Color fundus photograph: 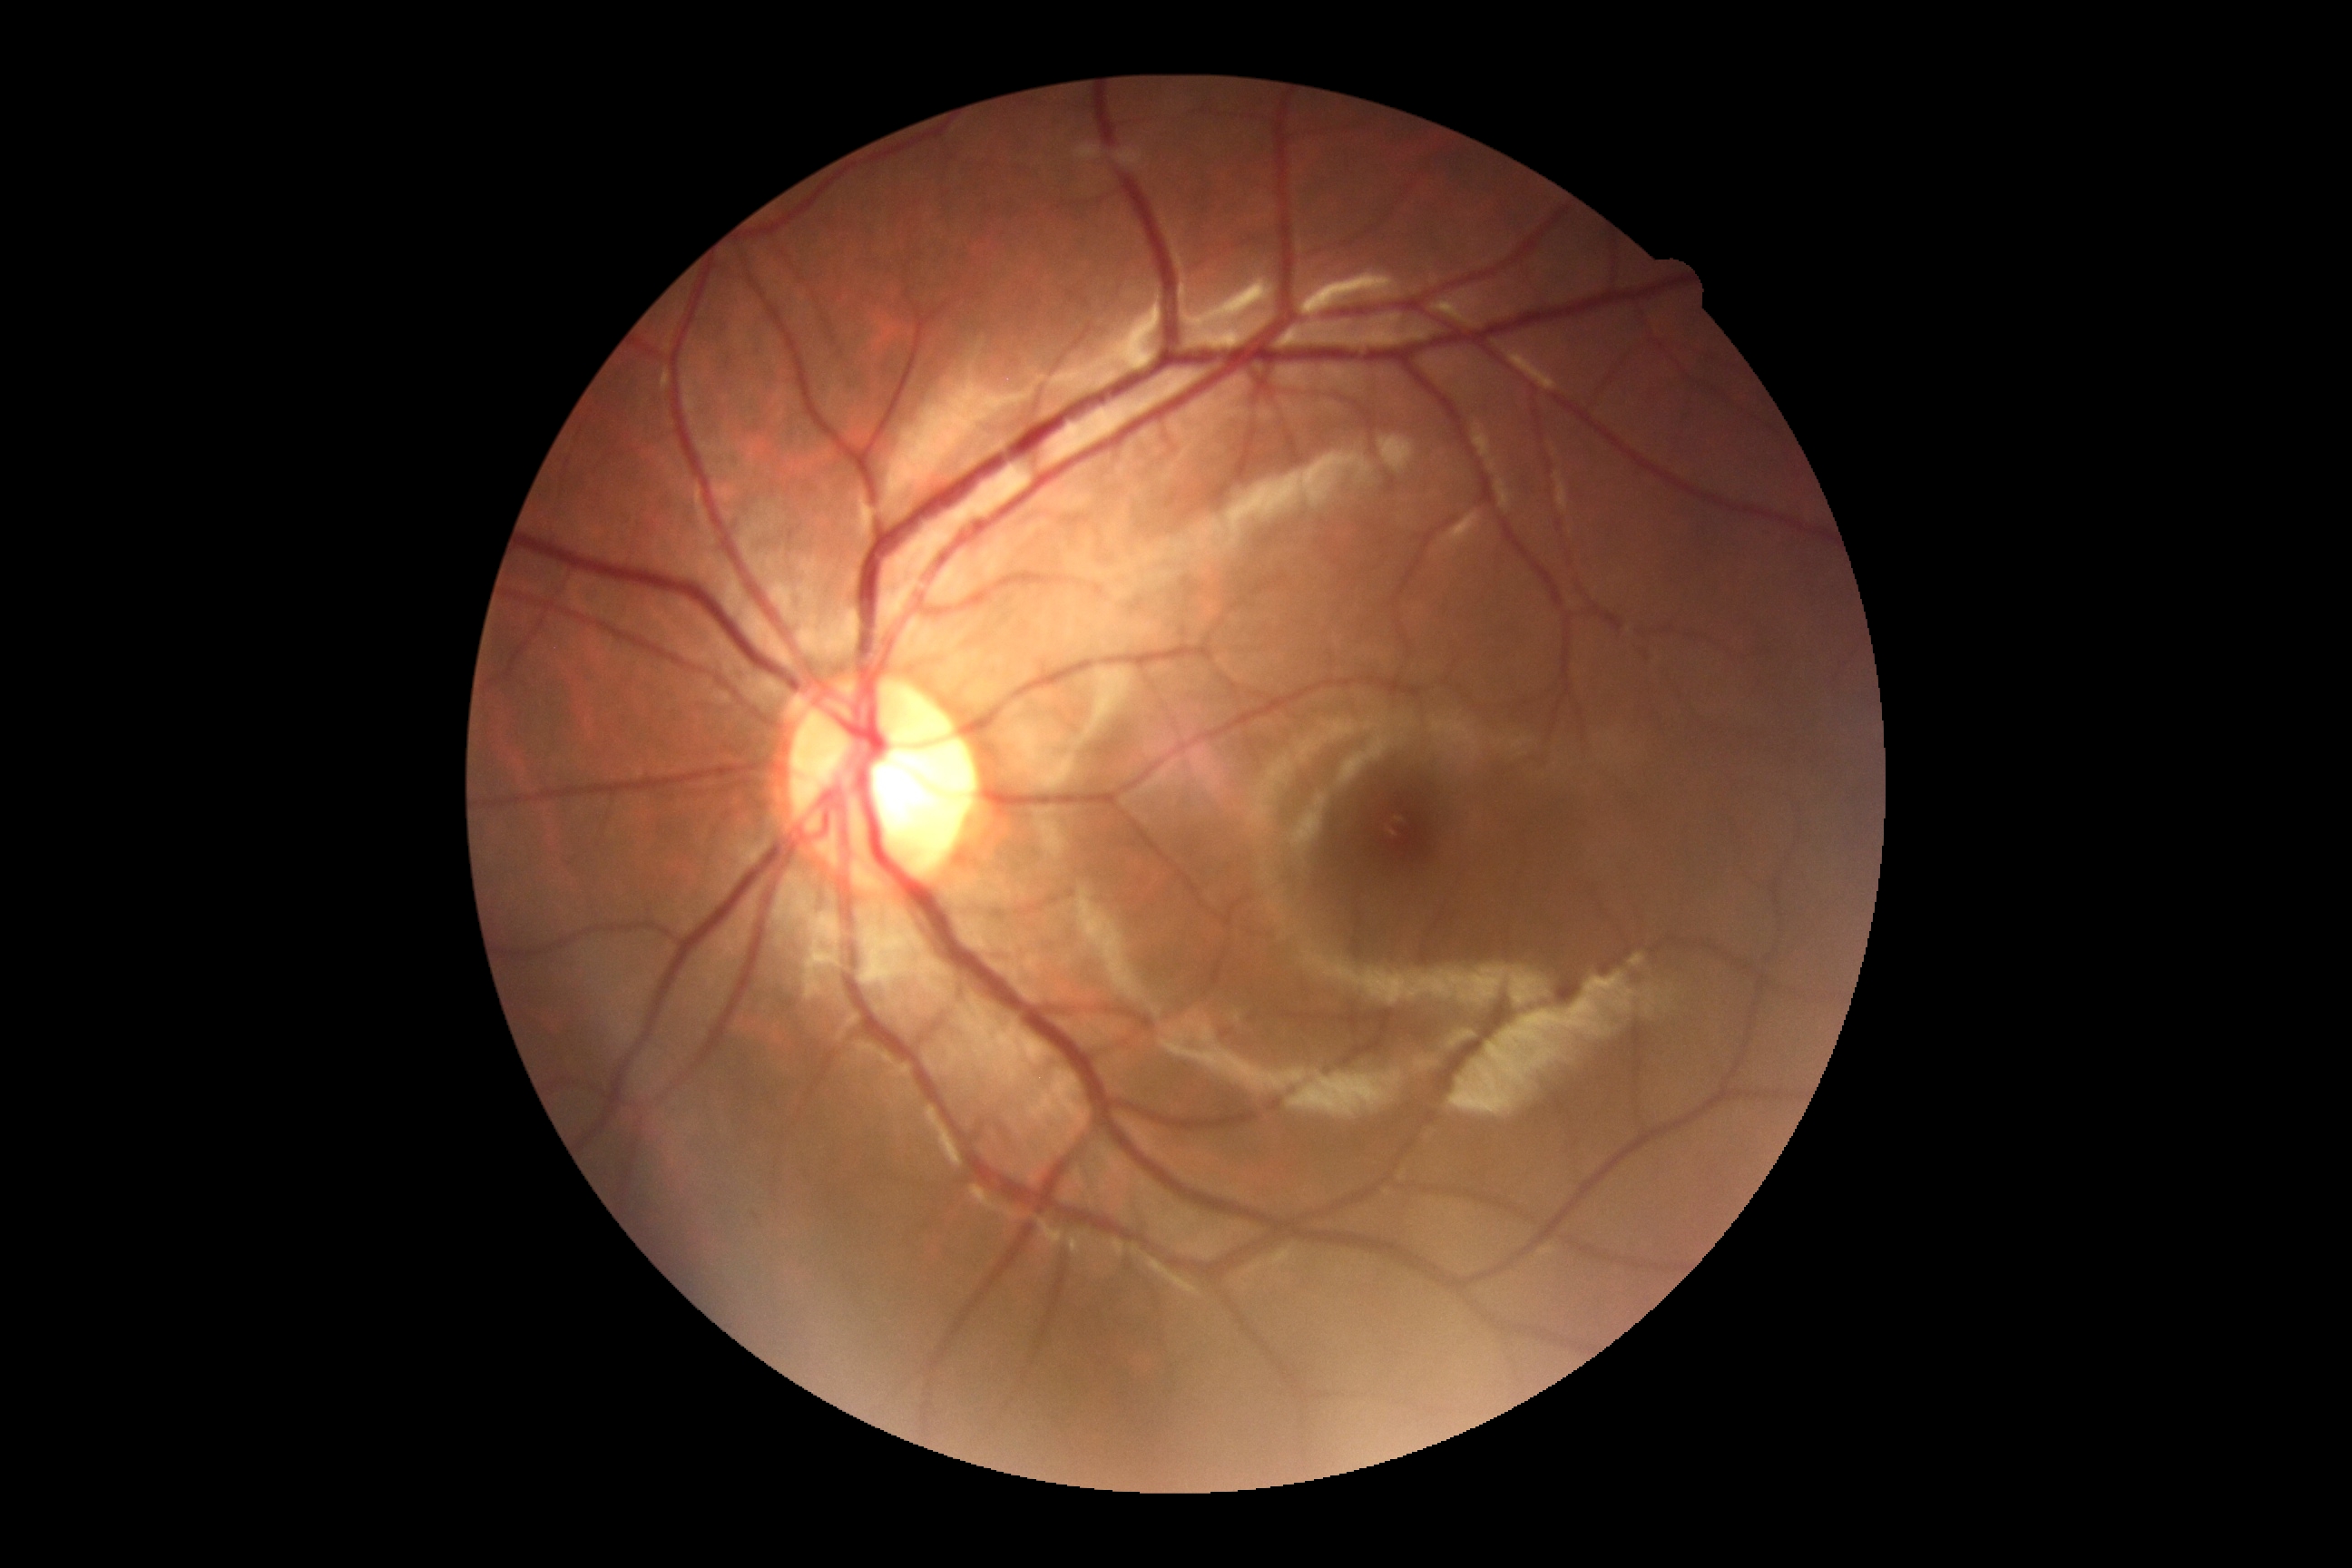

Retinopathy: grade 0 (no apparent retinopathy).